Captured with the Phoenix ICON (100° field of view); wide-field fundus photograph from neonatal ROP screening: 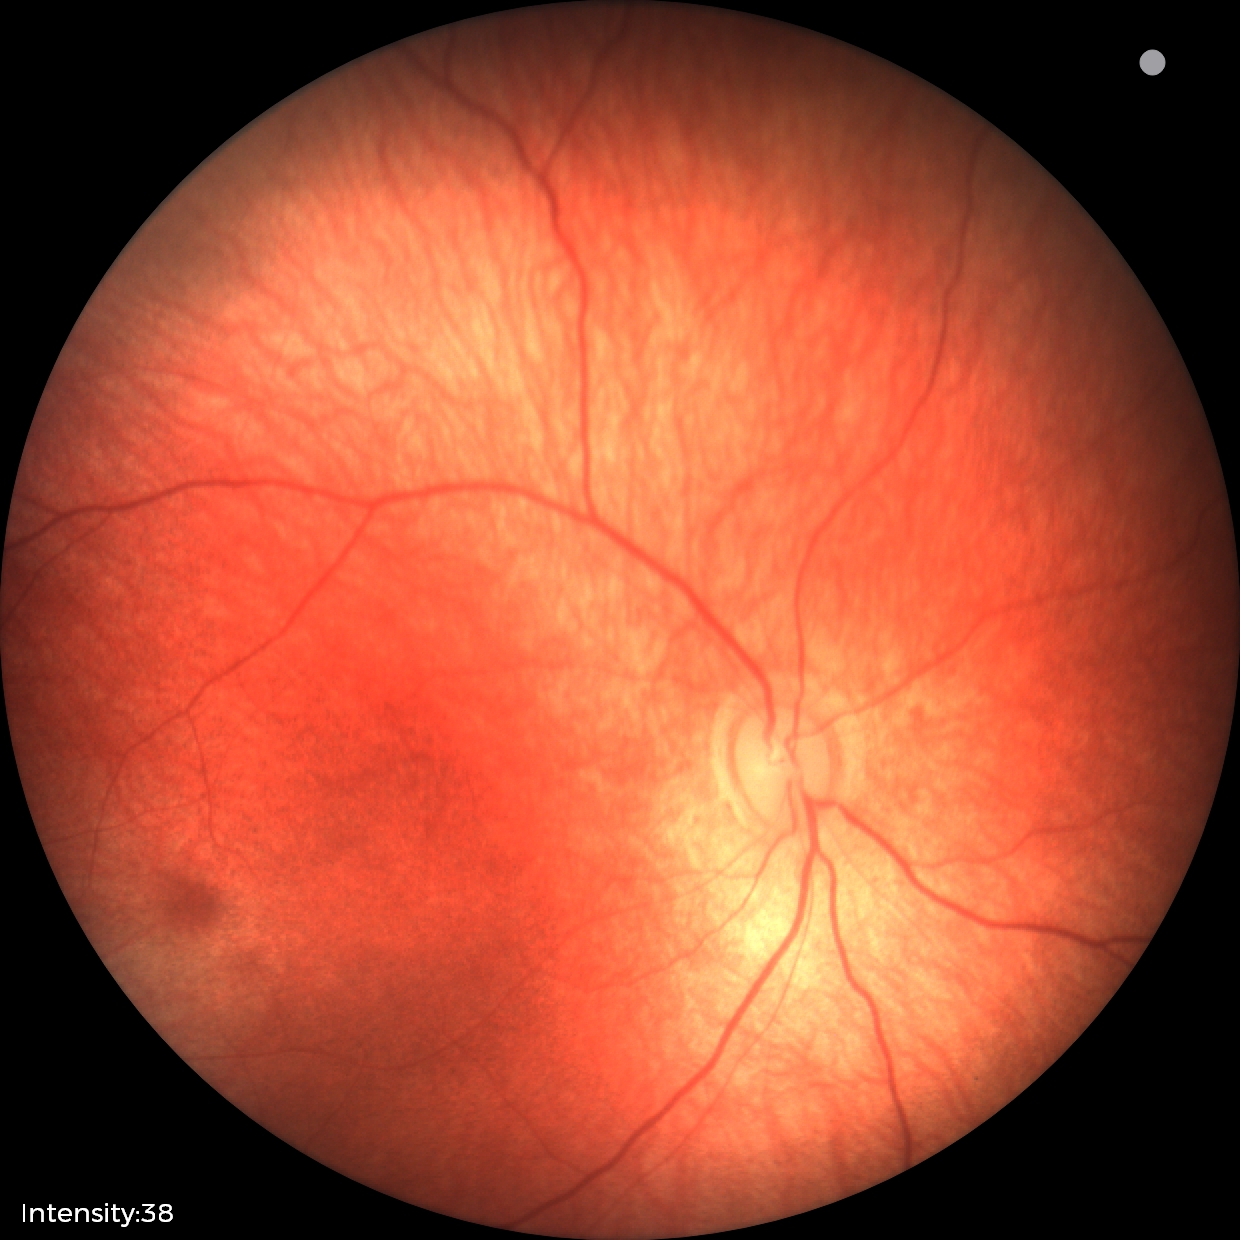 Screening examination with no abnormal retinal findings.